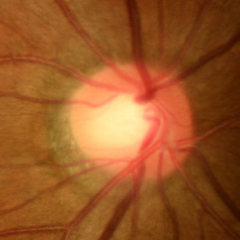
Impression: no glaucomatous changes.